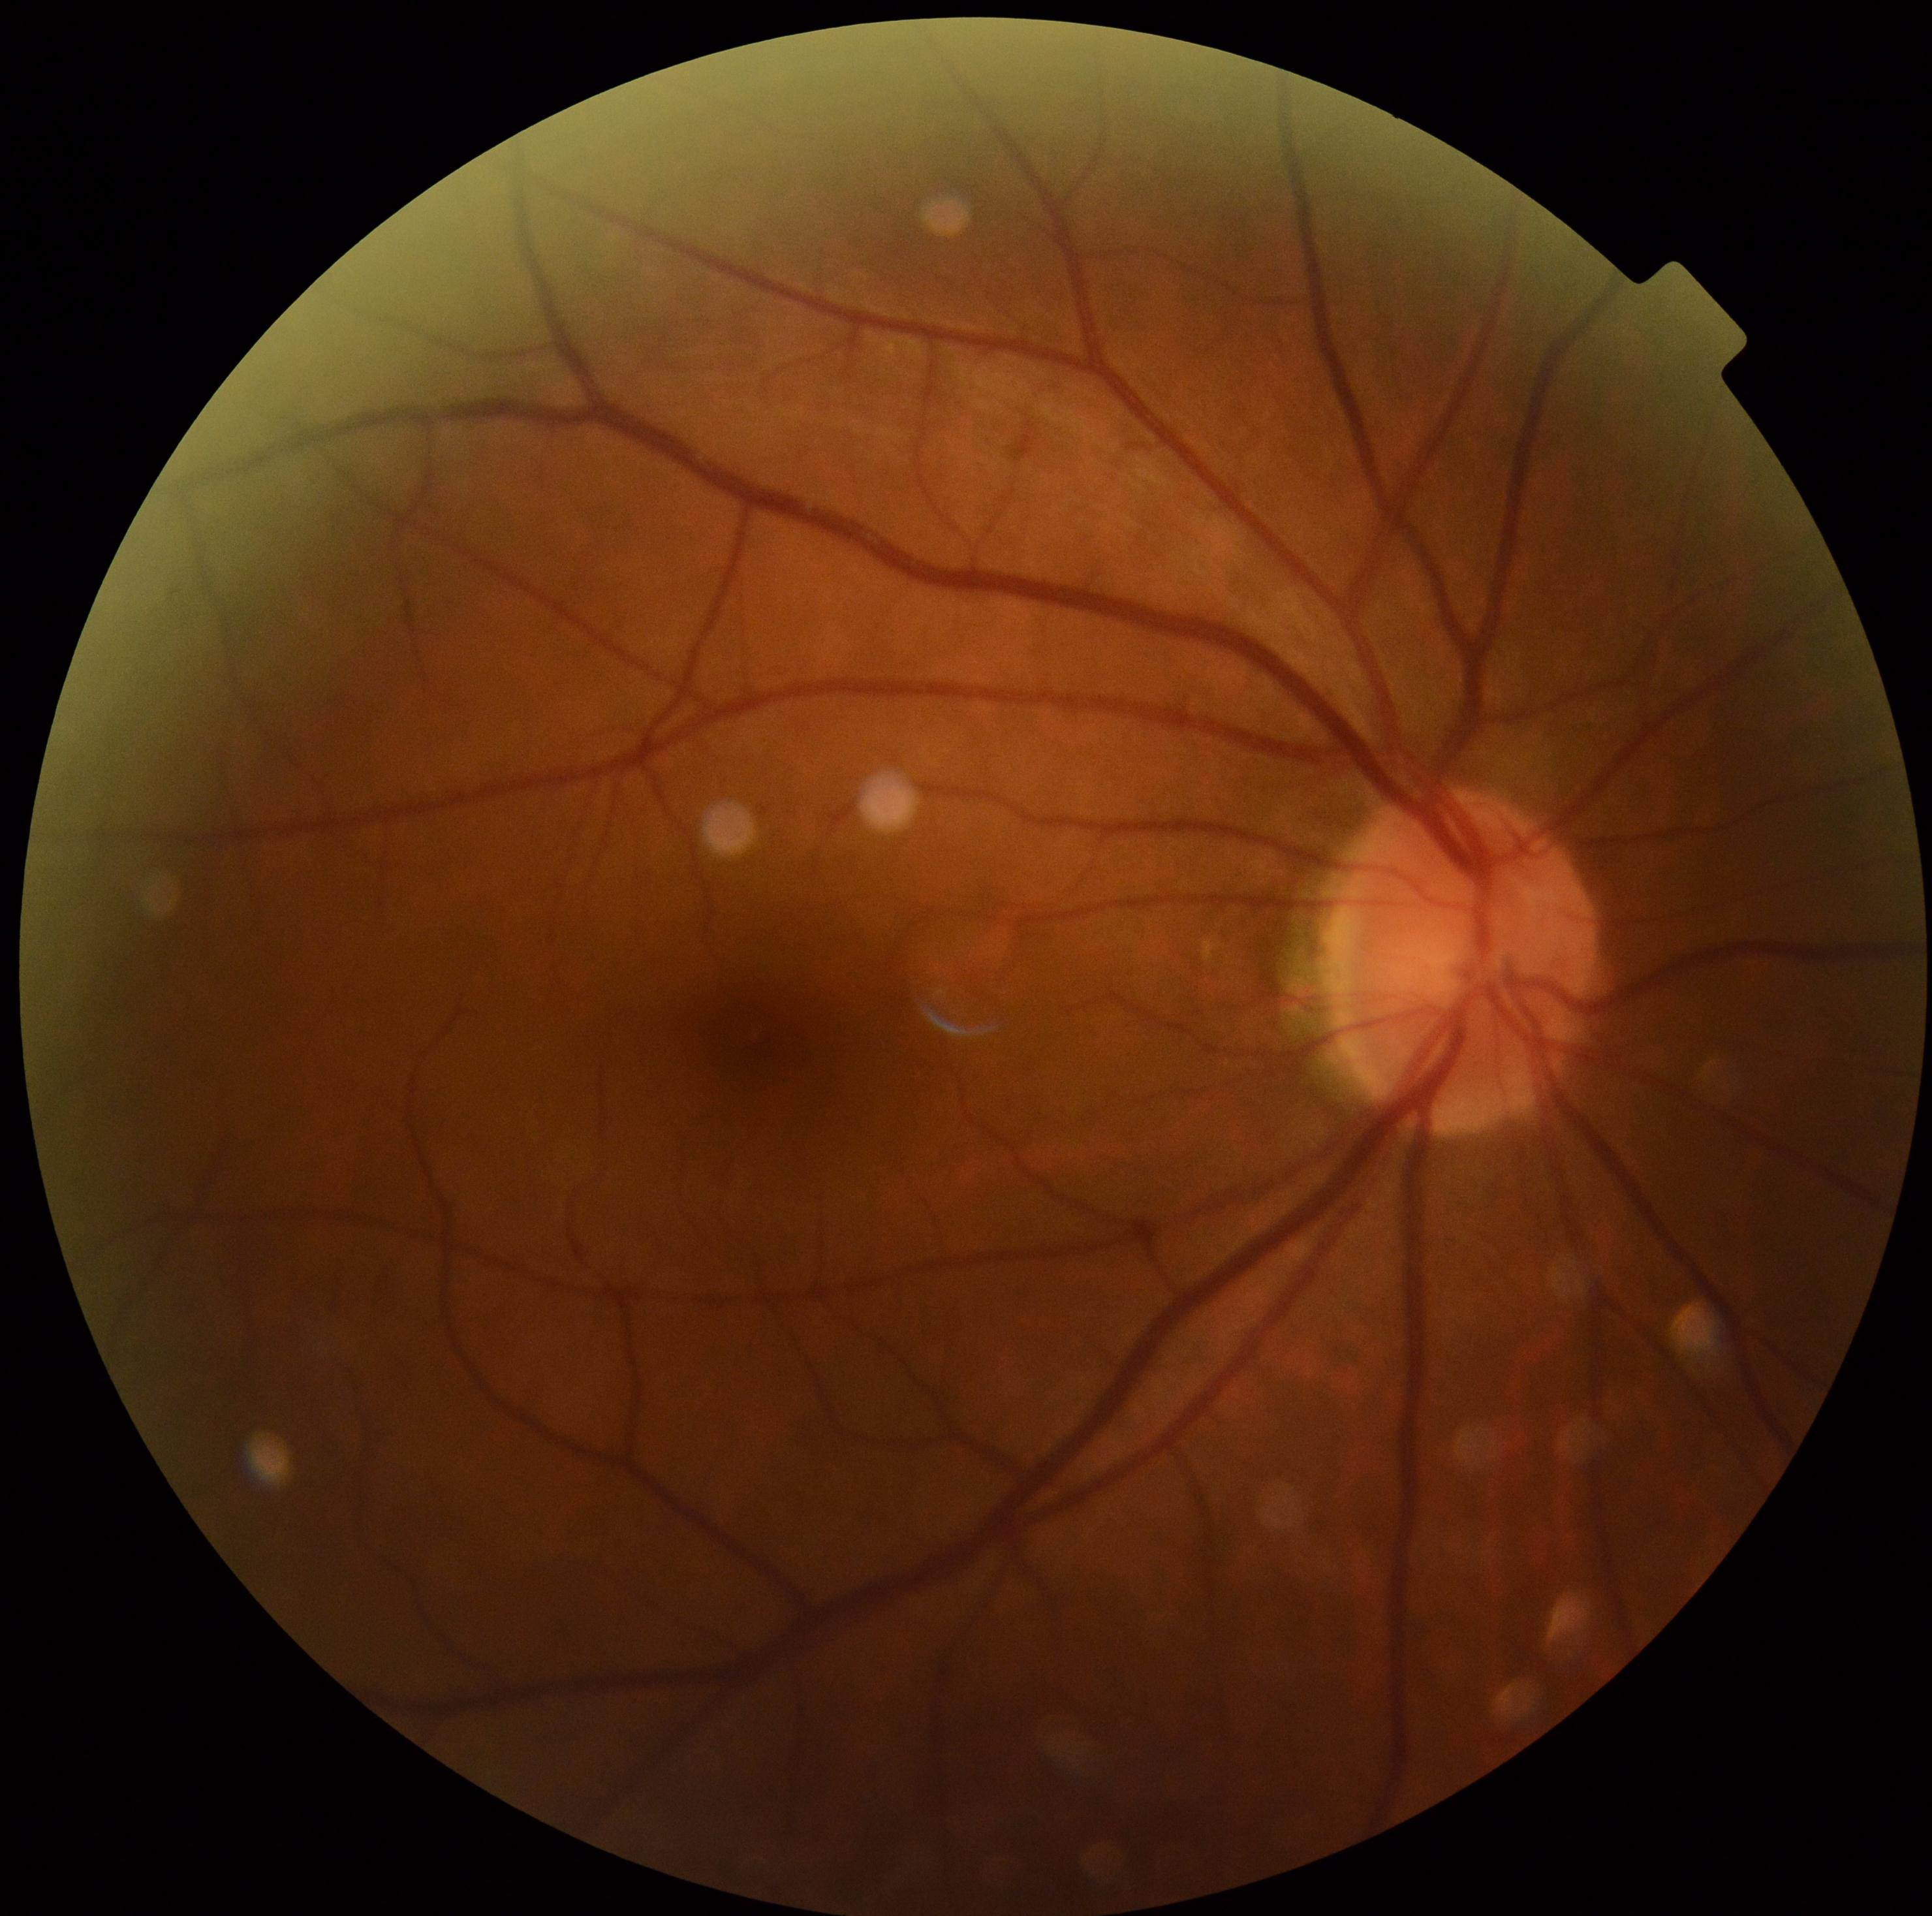

Retinopathy grade is 0/4. No diabetic retinal disease findings.